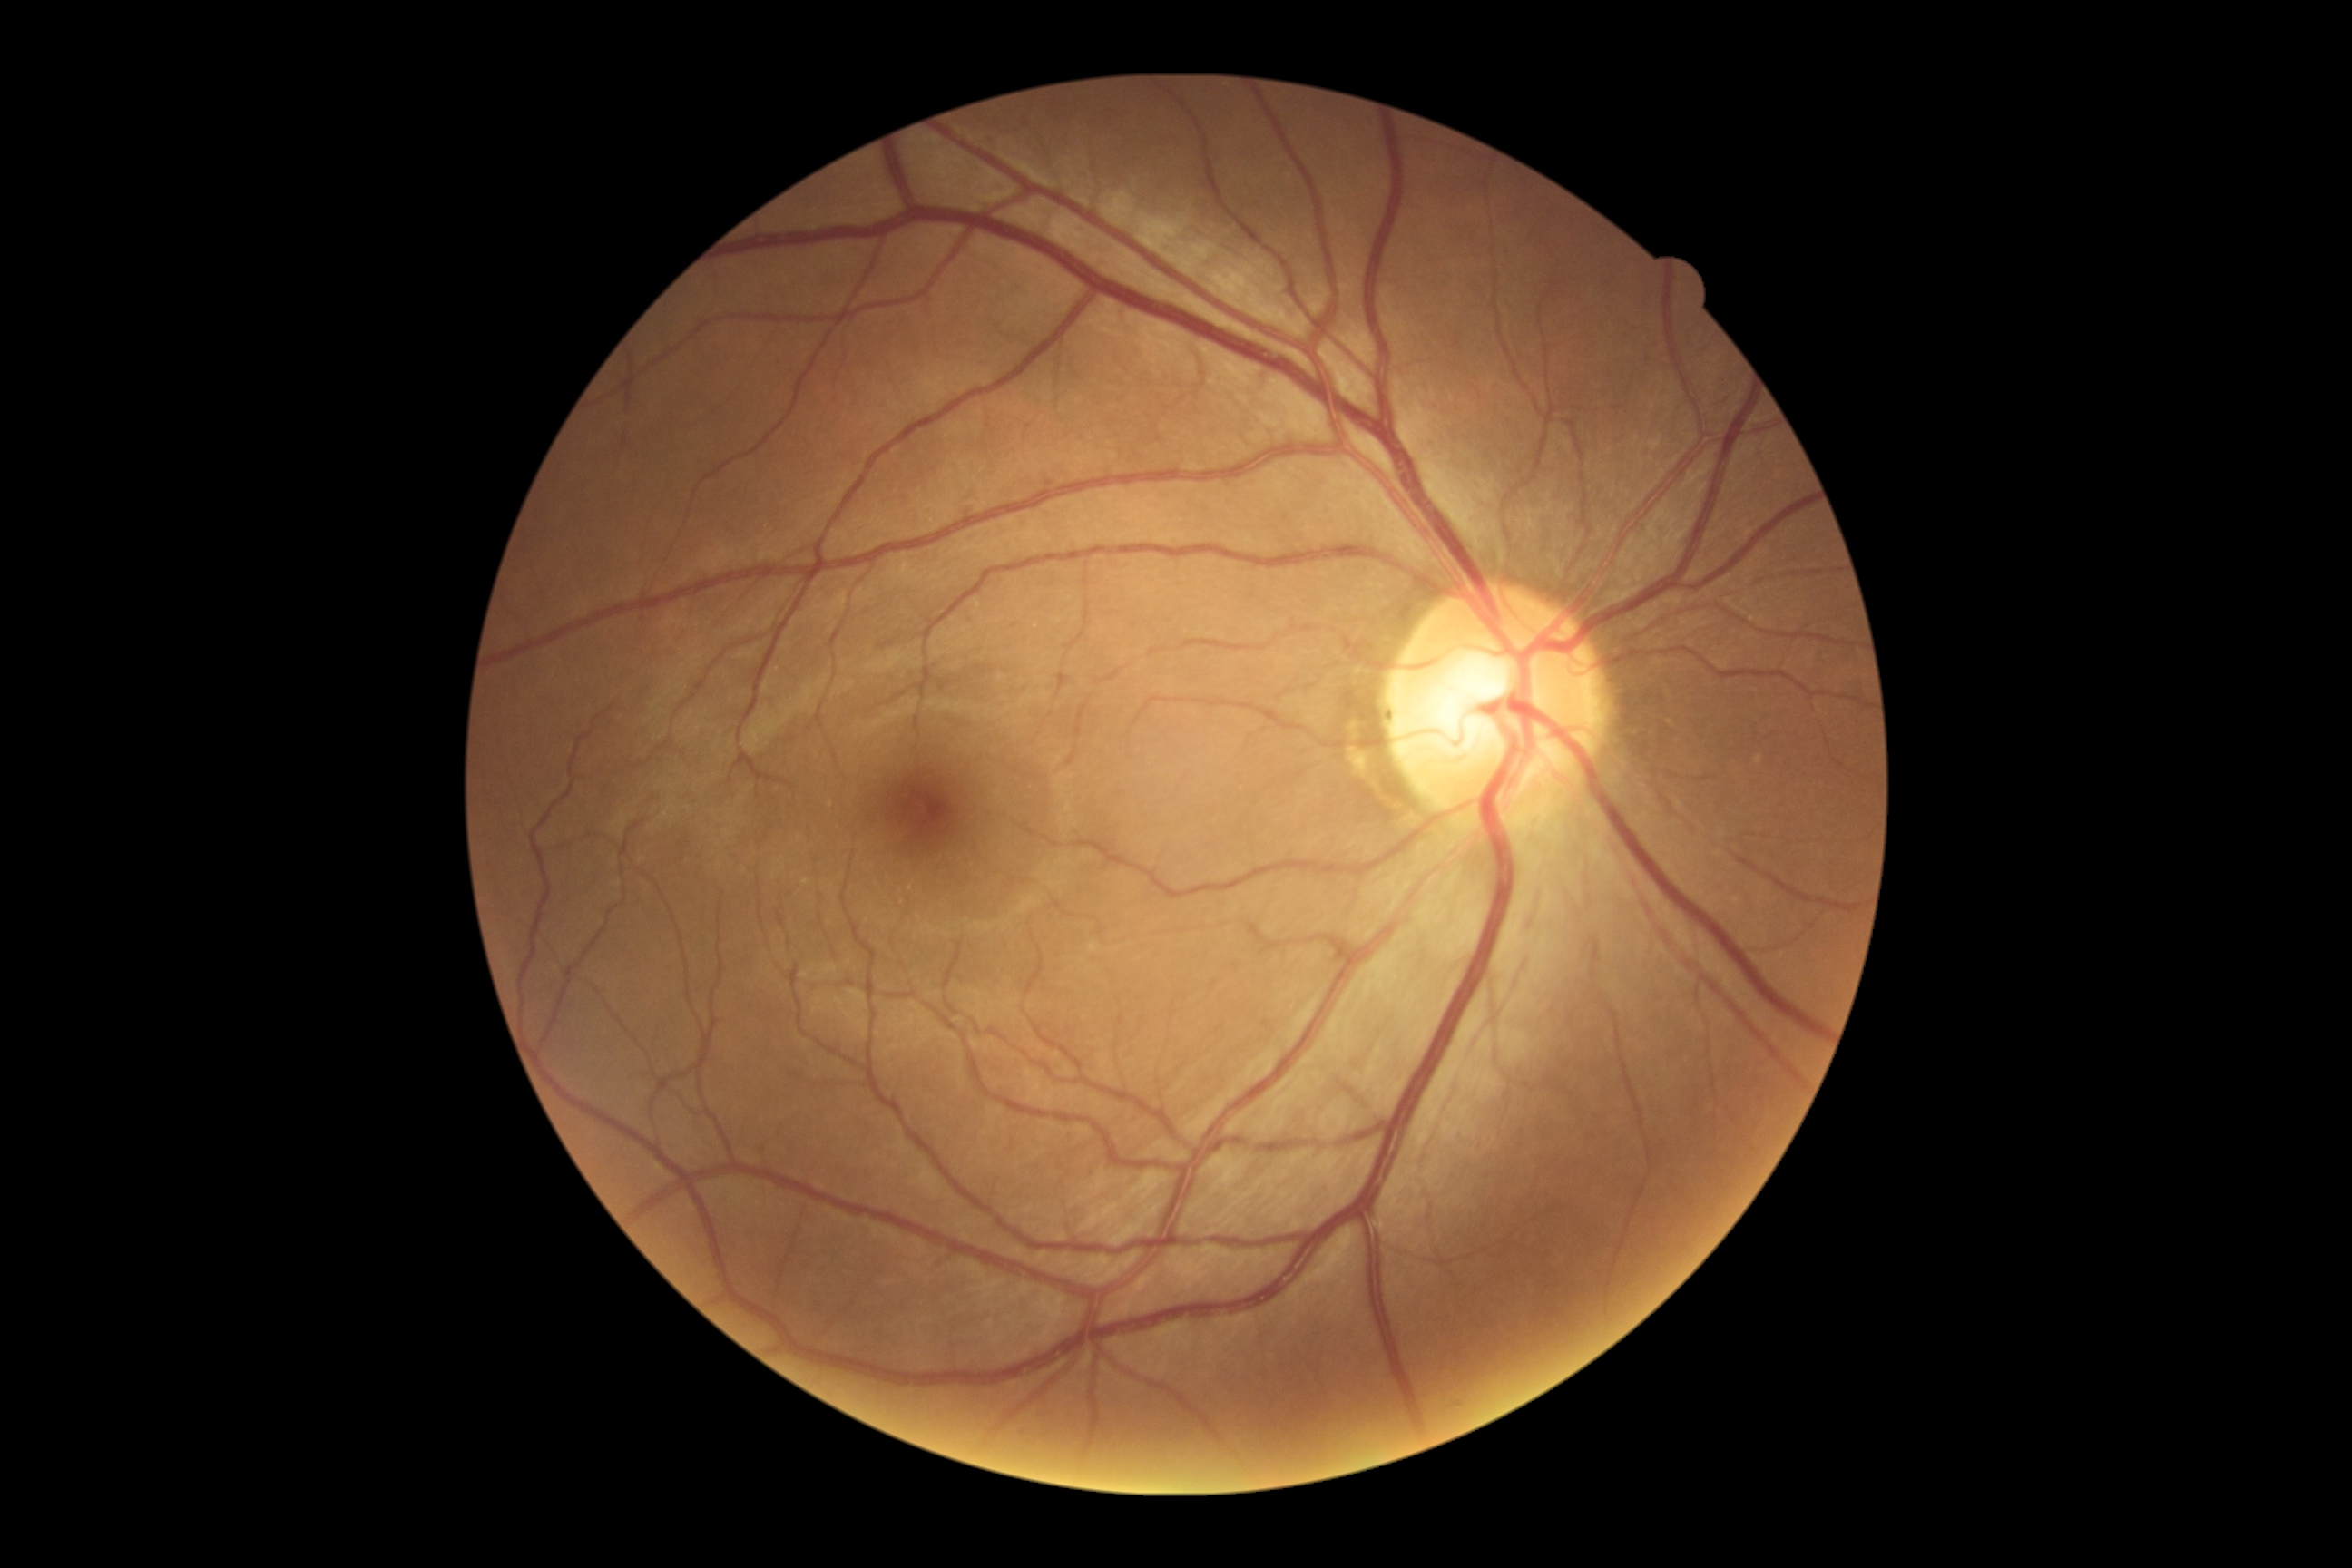

Annotations:
– DR: no apparent retinopathy (grade 0)